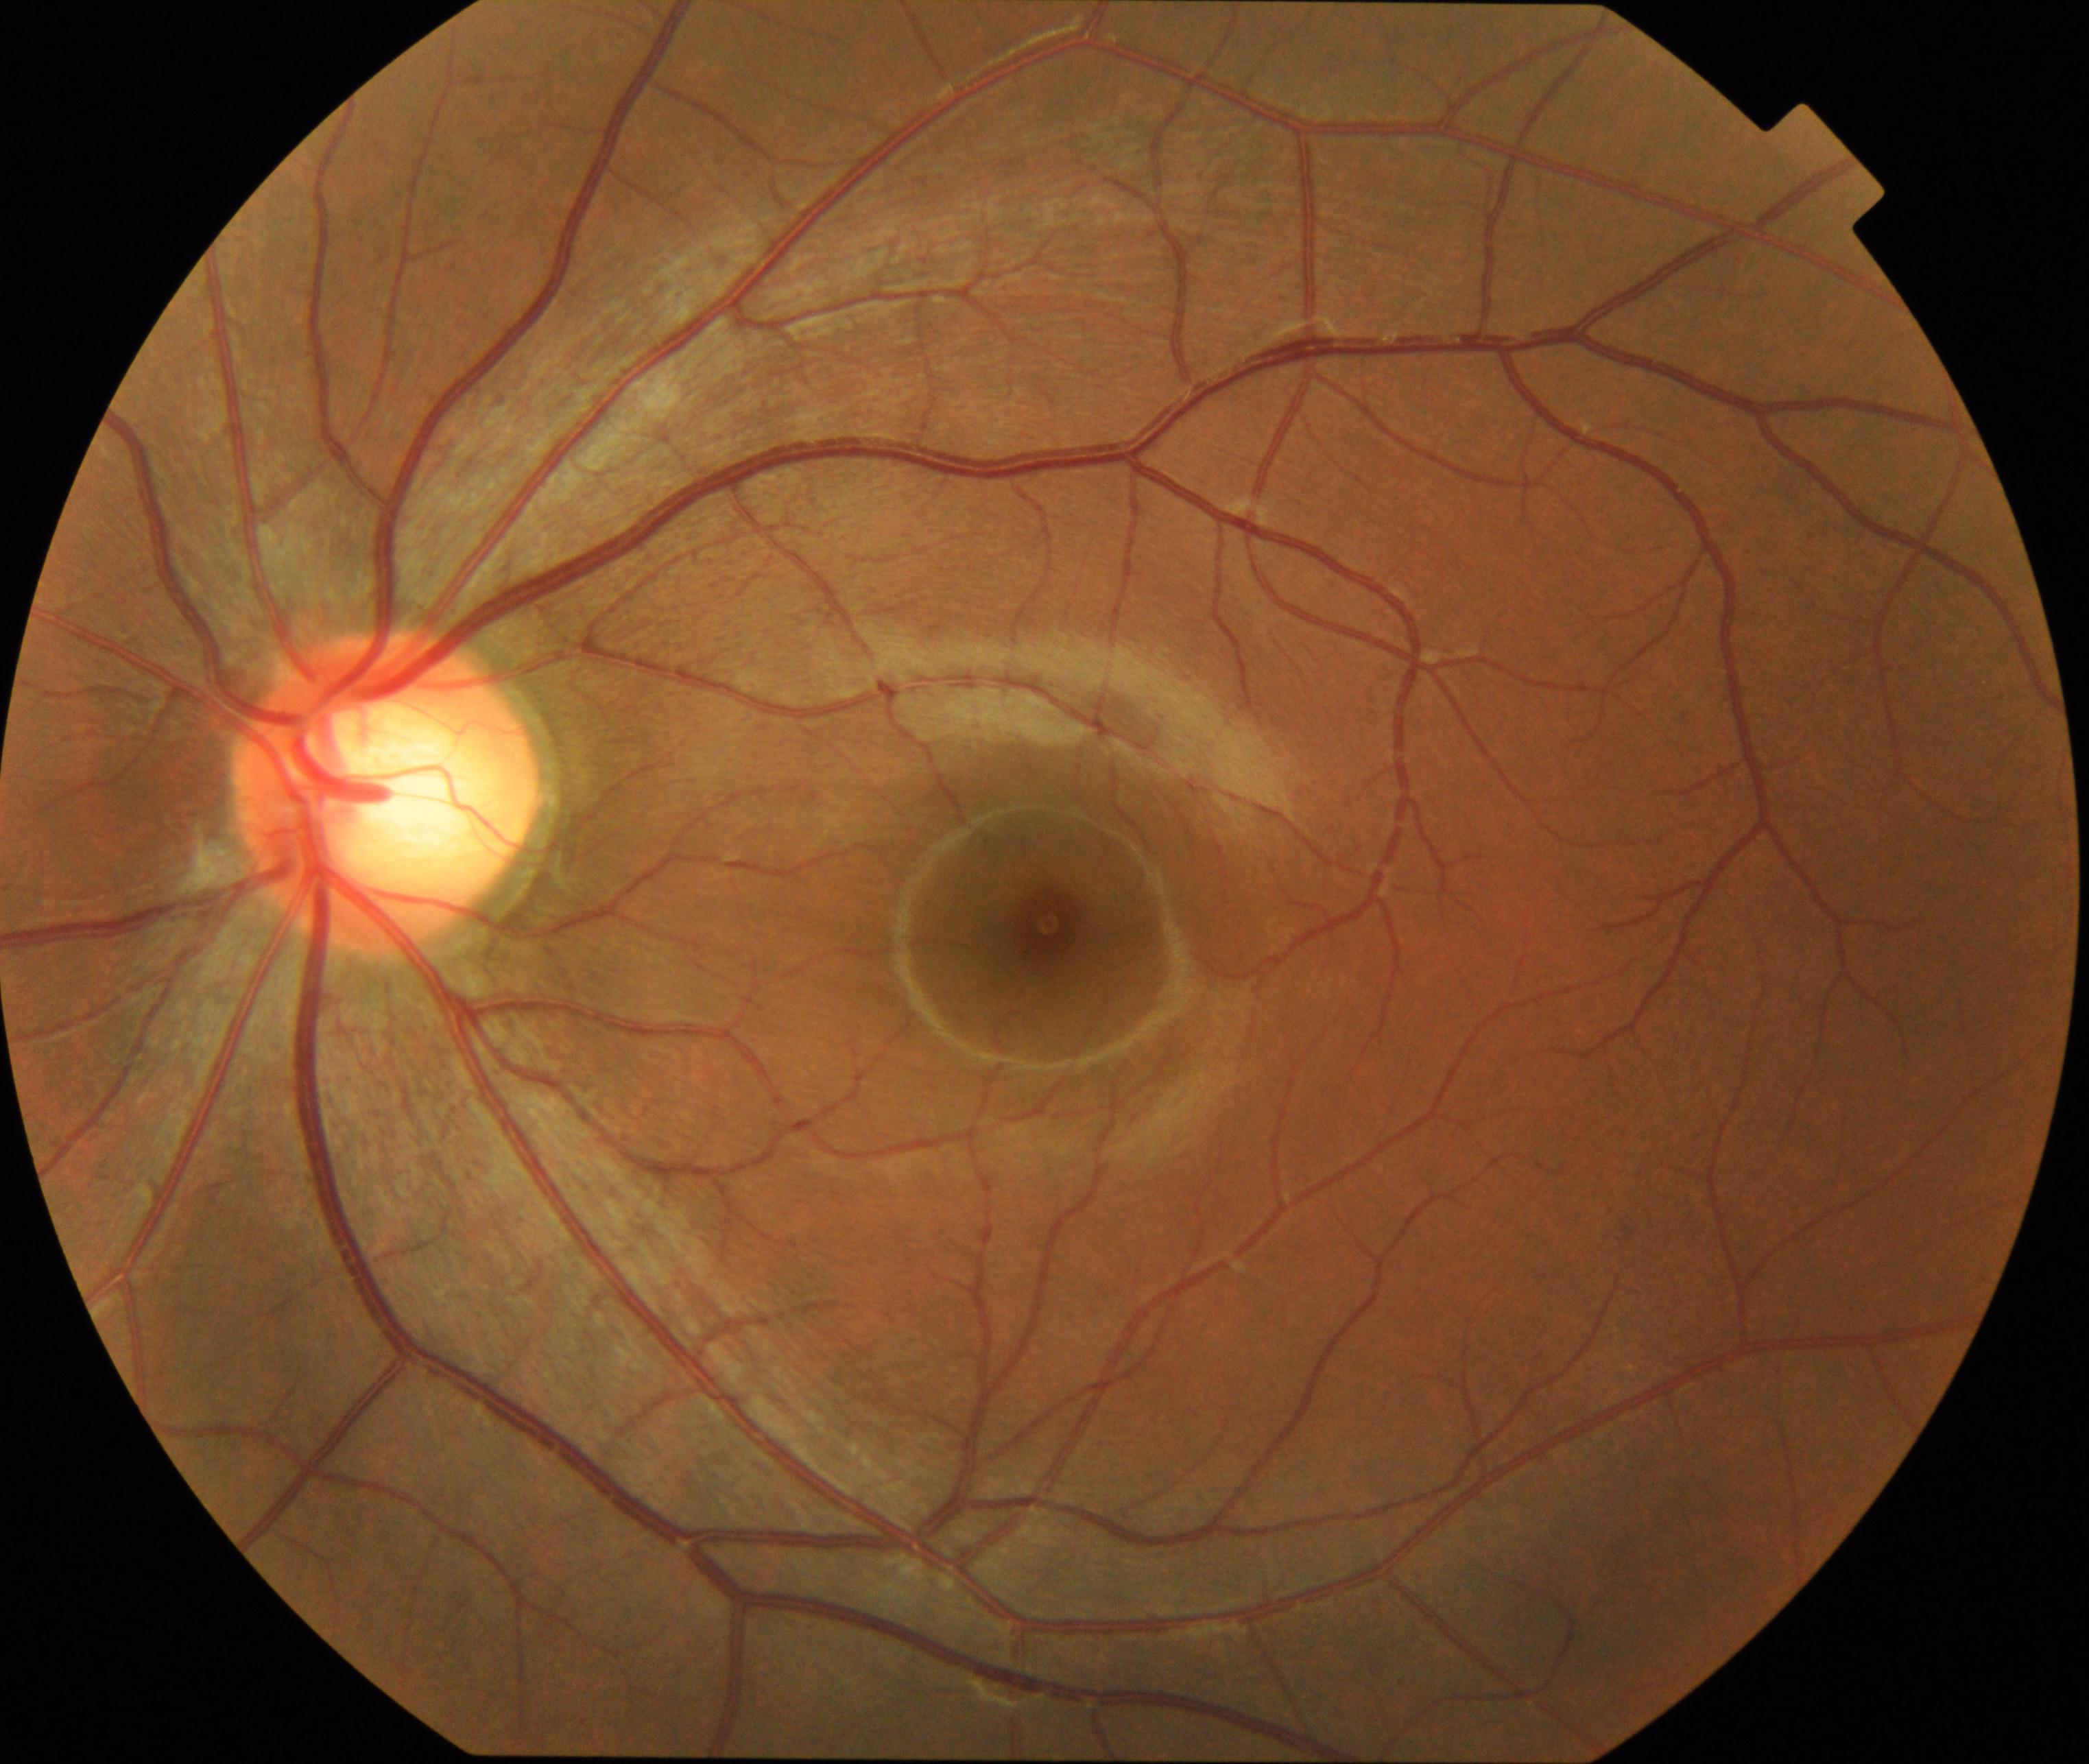 There is evidence of large optic cup.